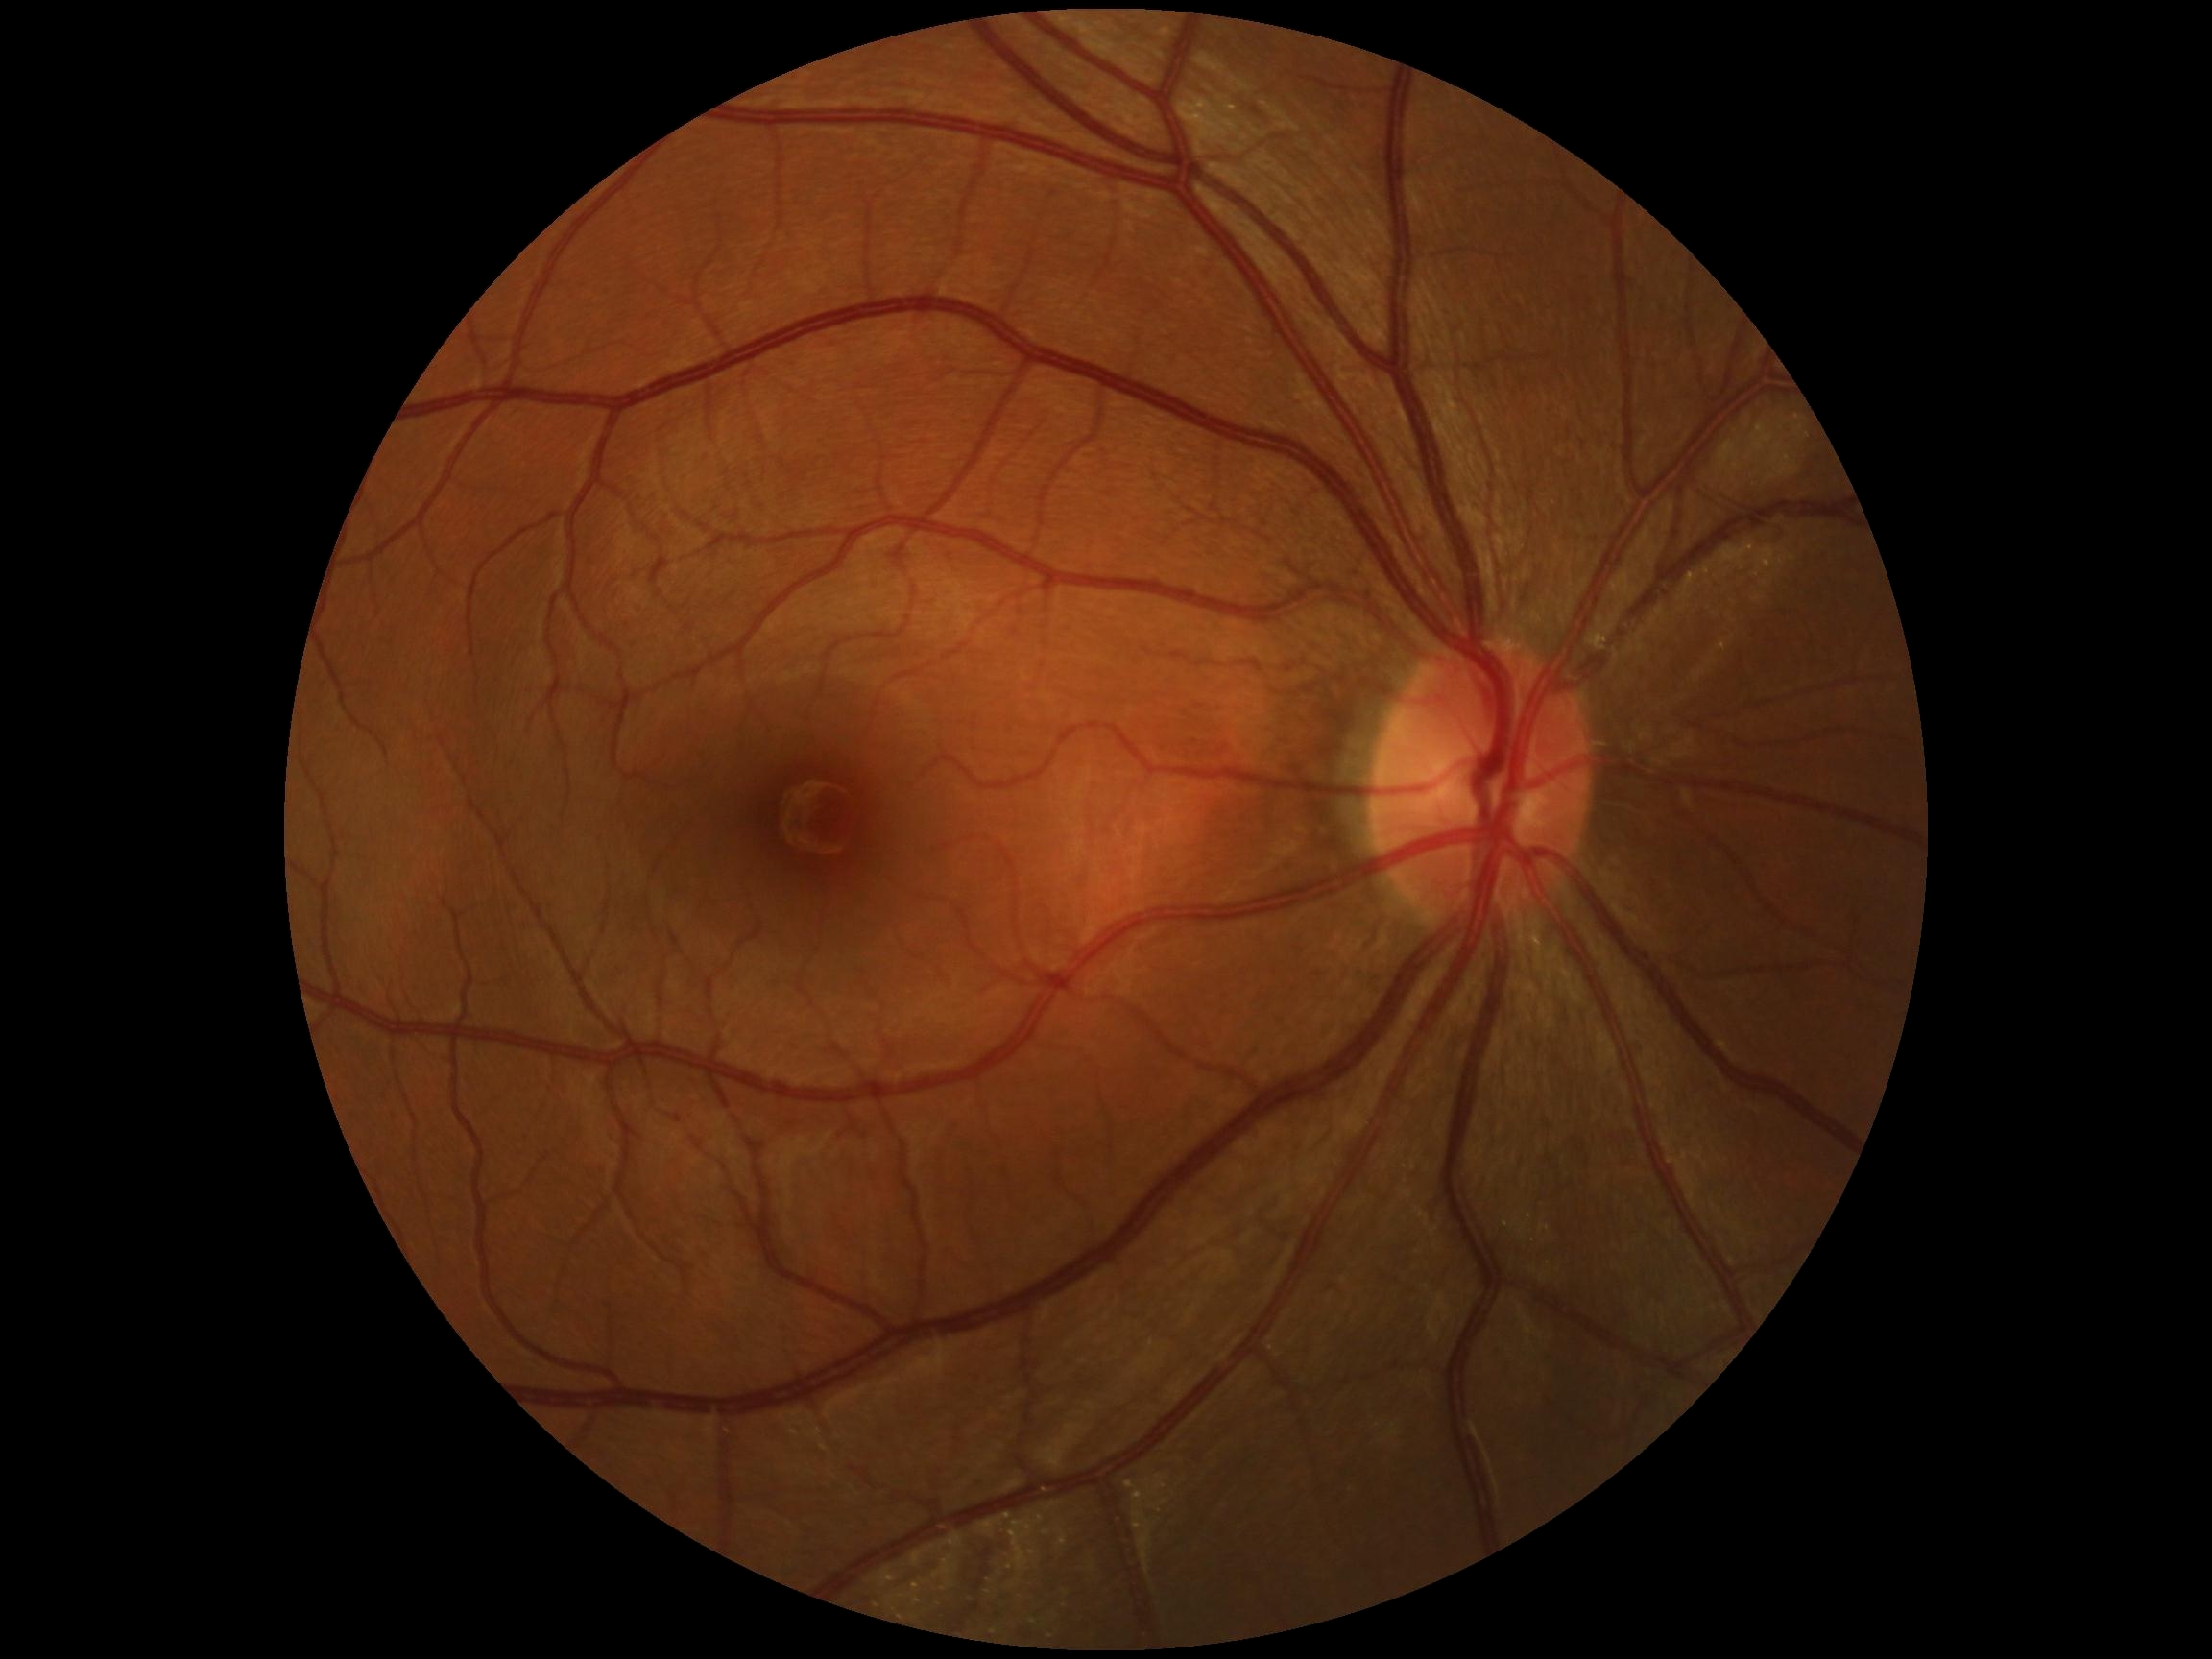

diabetic retinopathy=no apparent retinopathy (grade 0); DR impression=negative for DR.